UWF retinal mosaic — 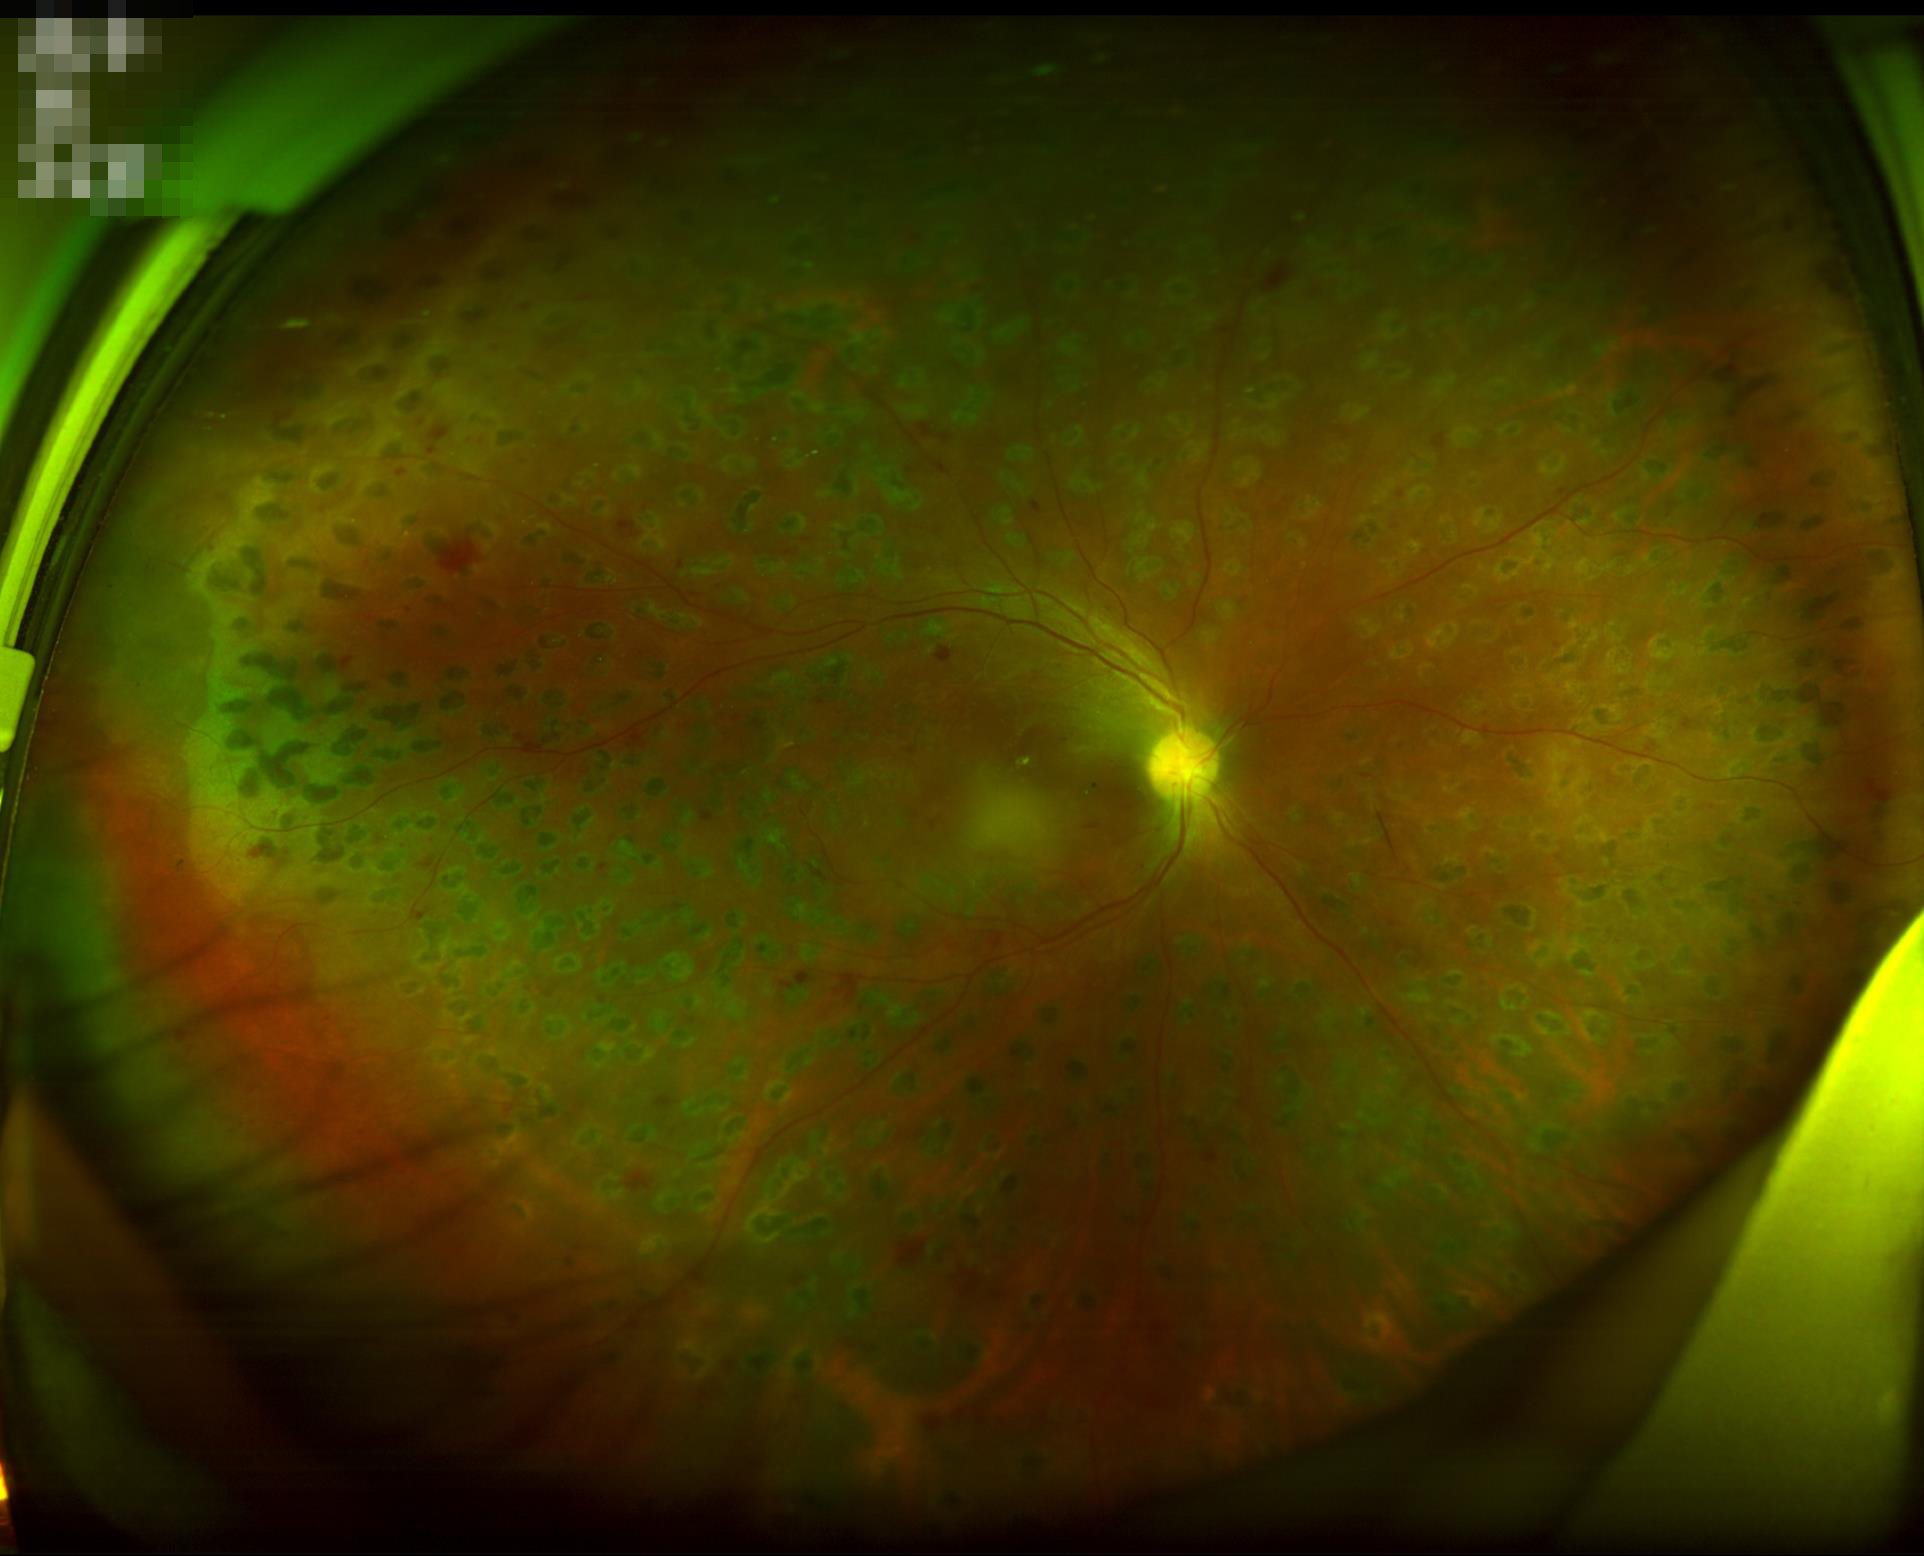   contrast: low
  illumination: adequate